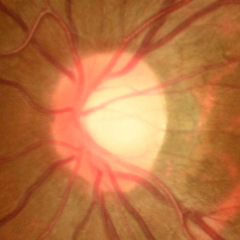 Optic disc photograph demonstrating no glaucoma.